Color fundus photograph. 45-degree field of view: 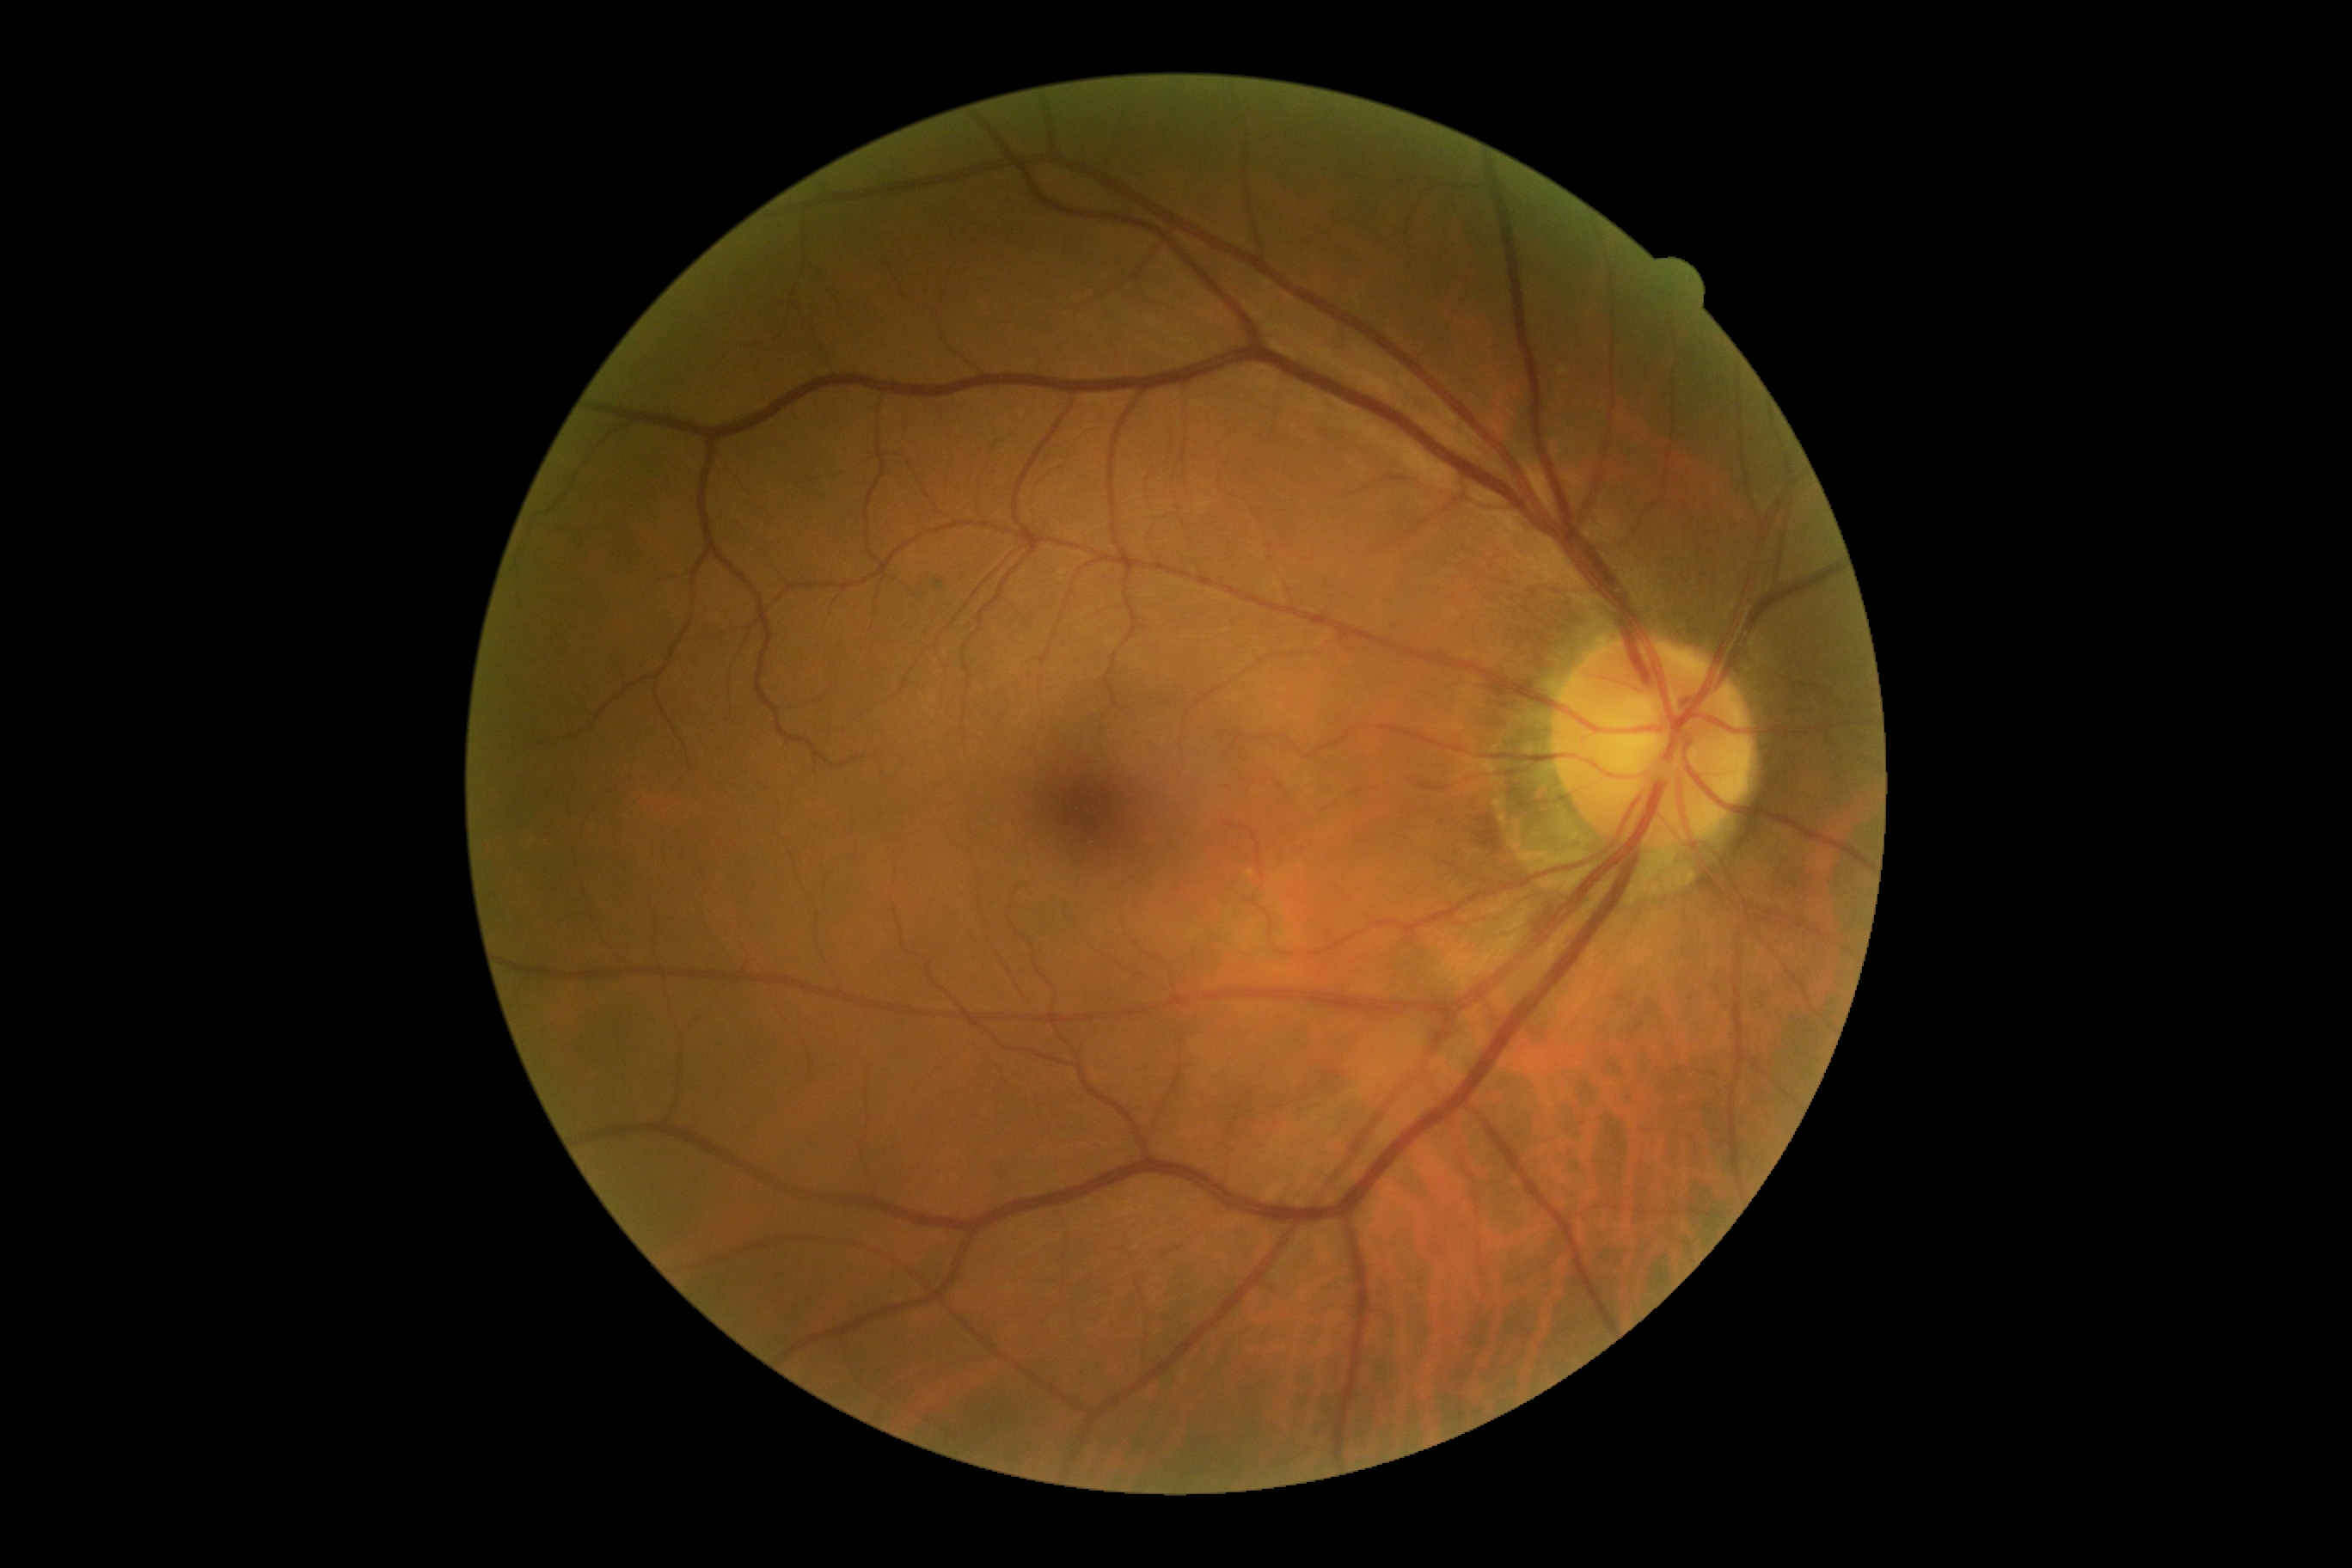

diabetic retinopathy severity = no apparent diabetic retinopathy (grade 0).